Nonmydriatic.
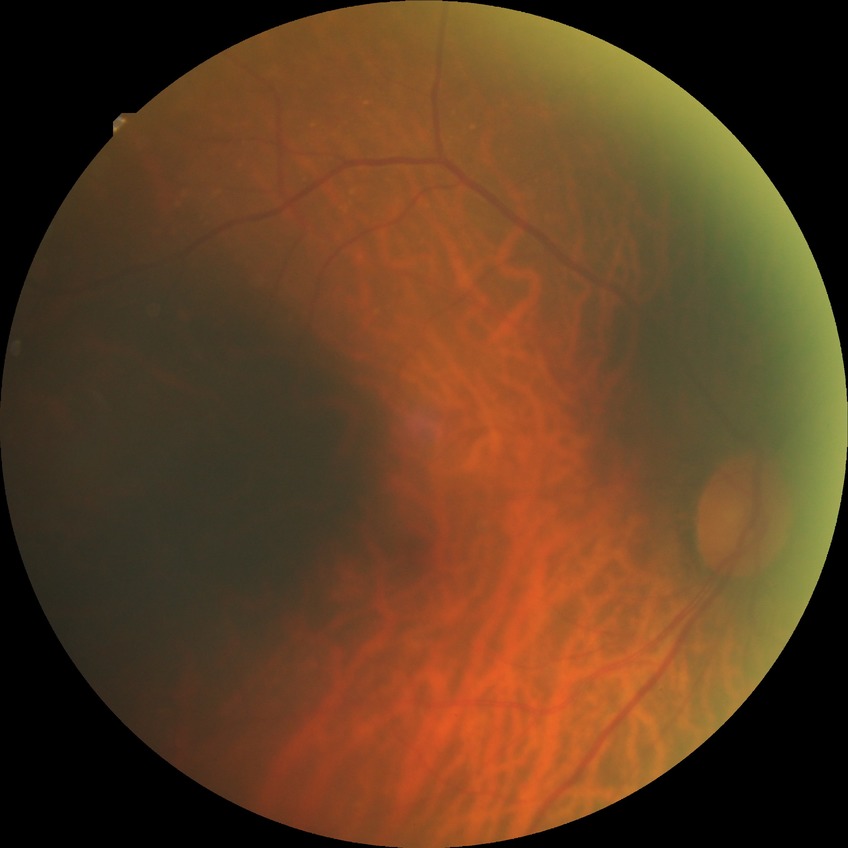
Diabetic retinopathy (DR) is NDR (no diabetic retinopathy).